45-degree field of view.
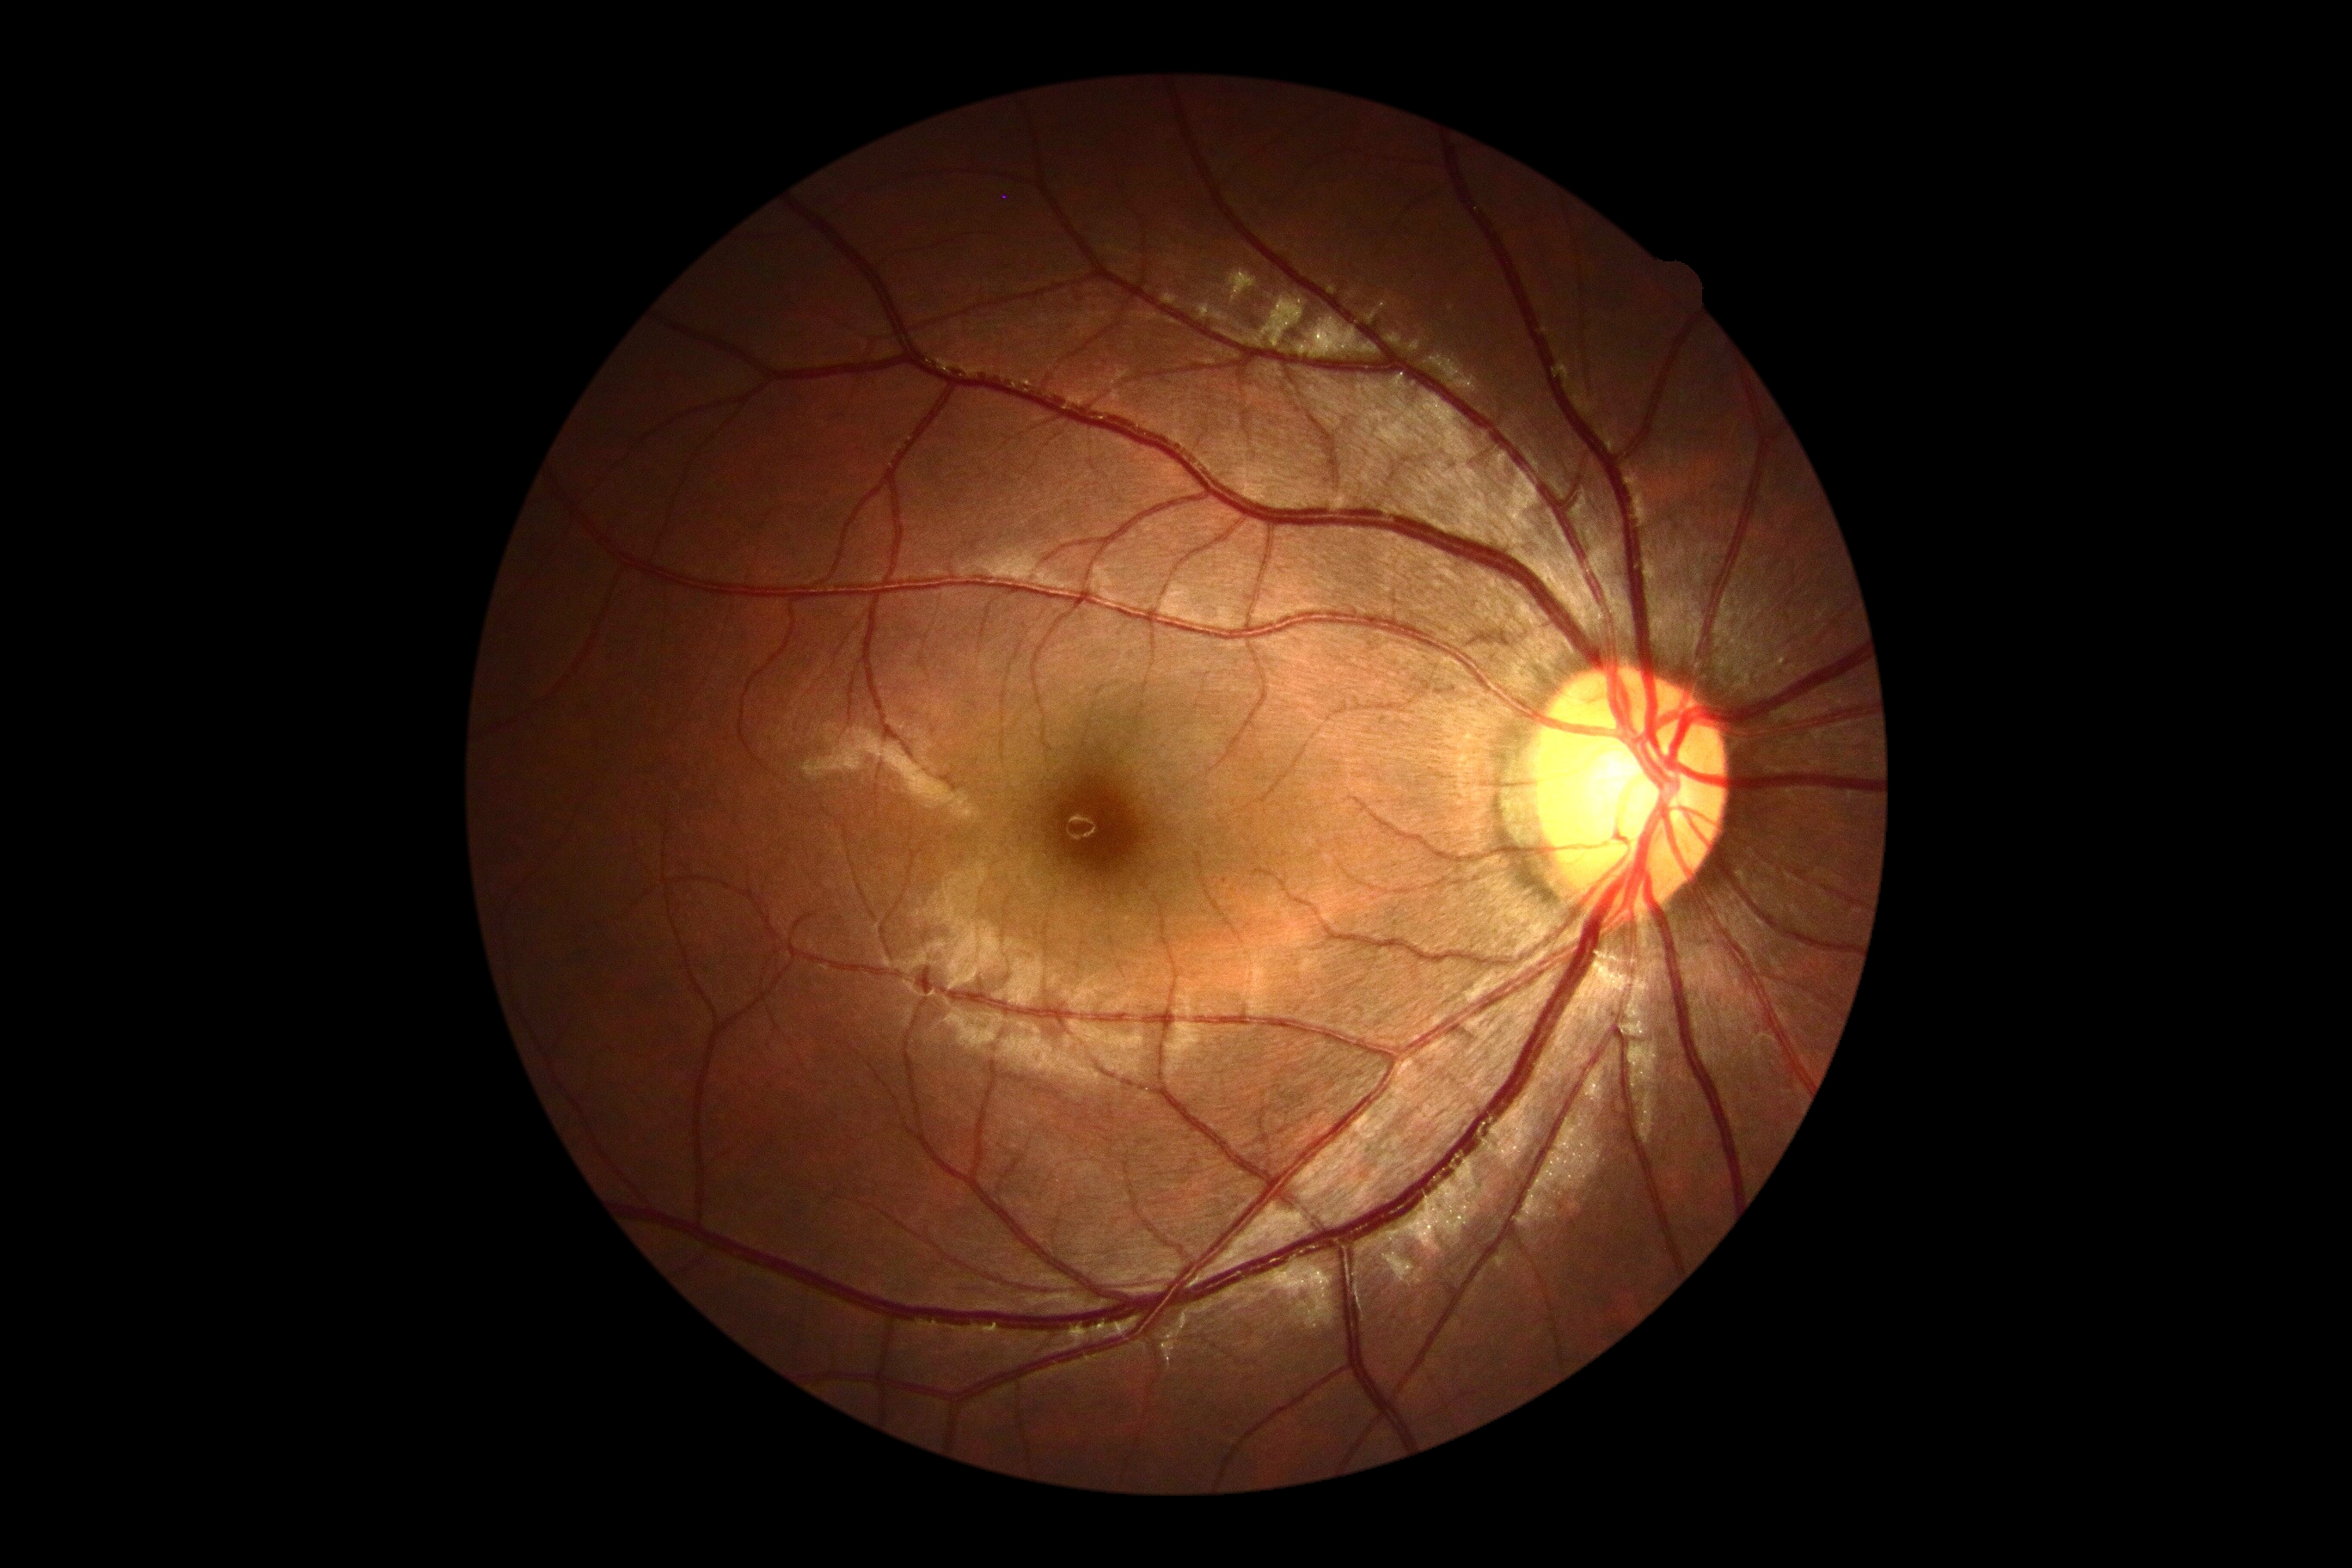

DR is grade 0 (no apparent retinopathy).